Phoenix ICON, 100° FOV · 1240 x 1240 pixels · wide-field fundus photograph of an infant: 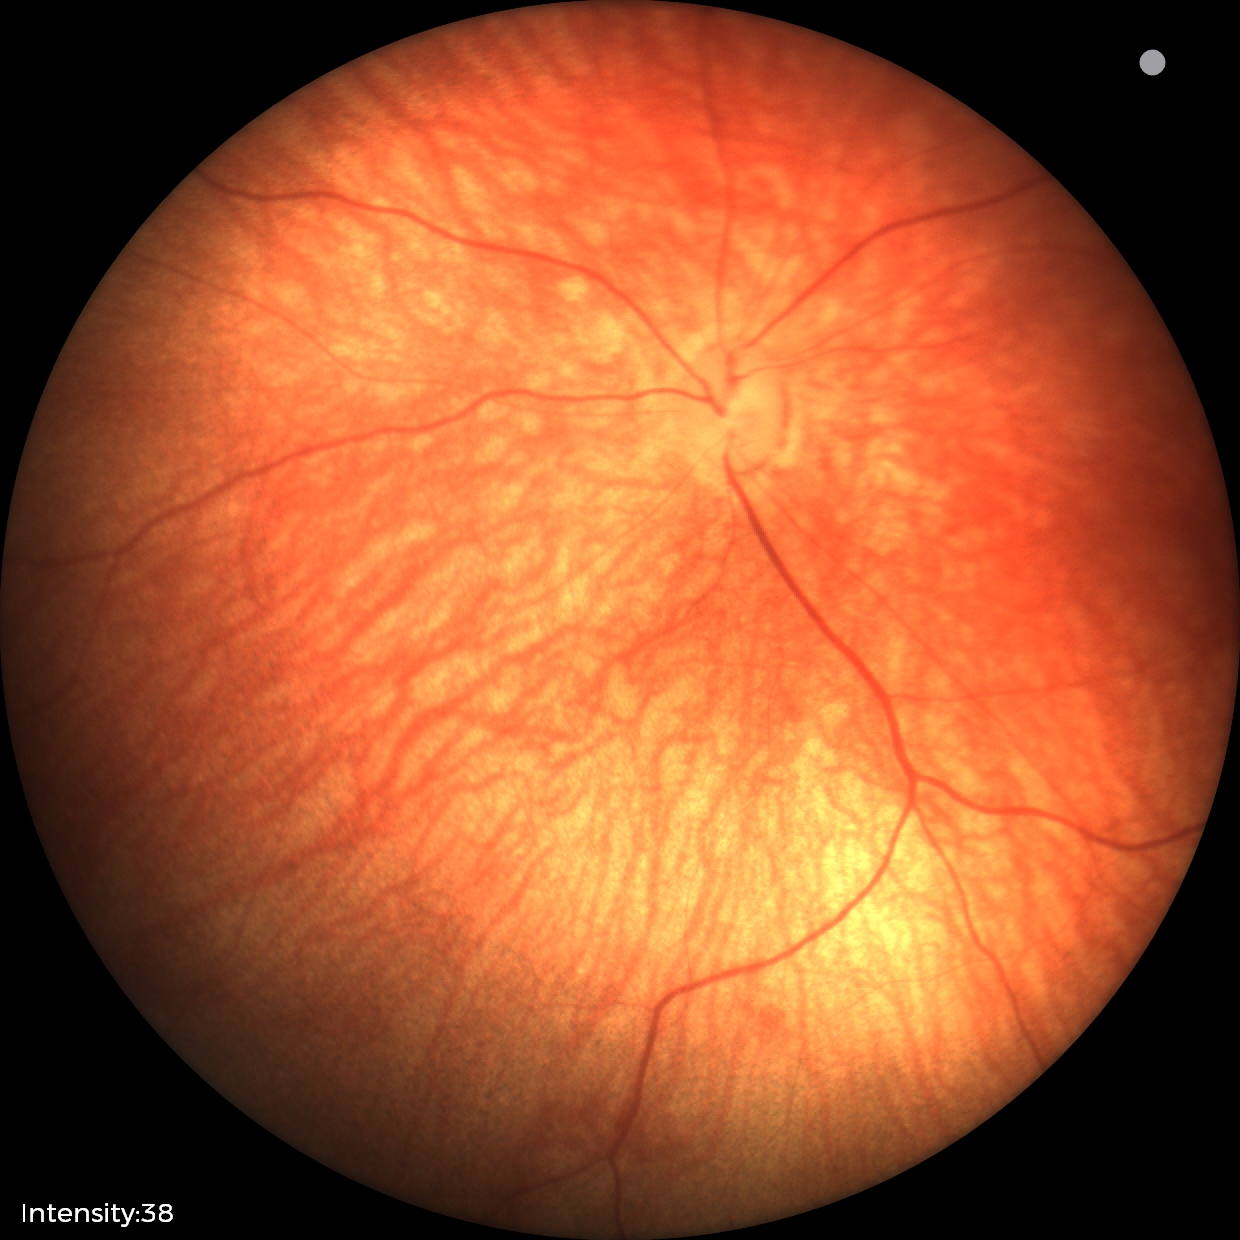
Screening examination consistent with retinal hemorrhages.